NIDEK AFC-230 fundus camera · no pharmacologic dilation · DR severity per modified Davis staging:
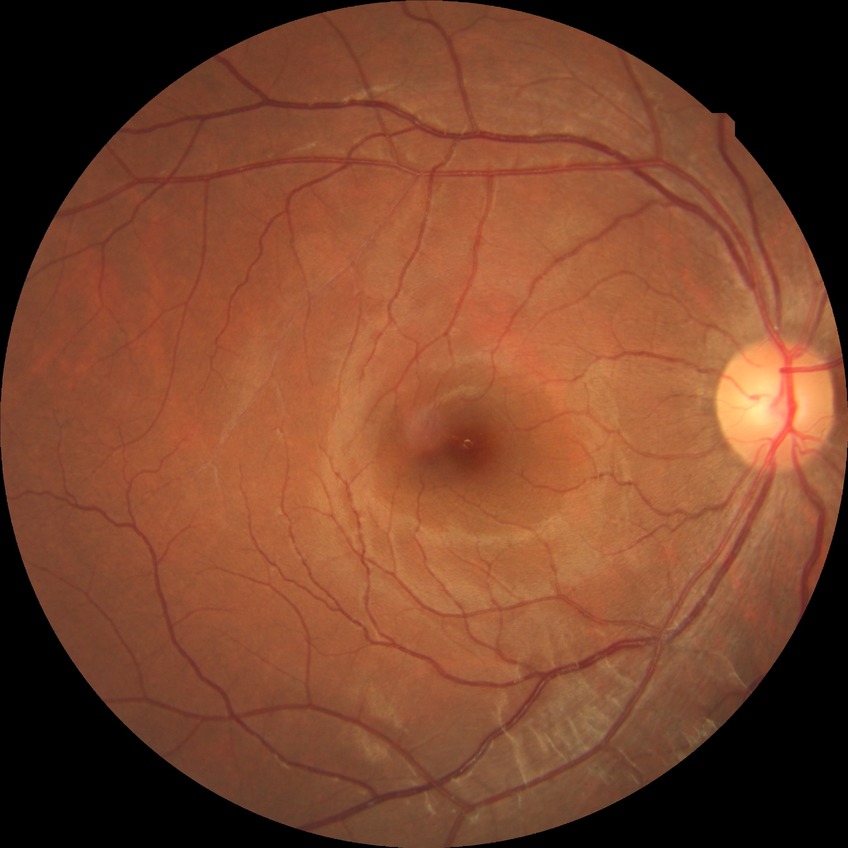
Diabetic retinopathy (DR) is NDR (no diabetic retinopathy).